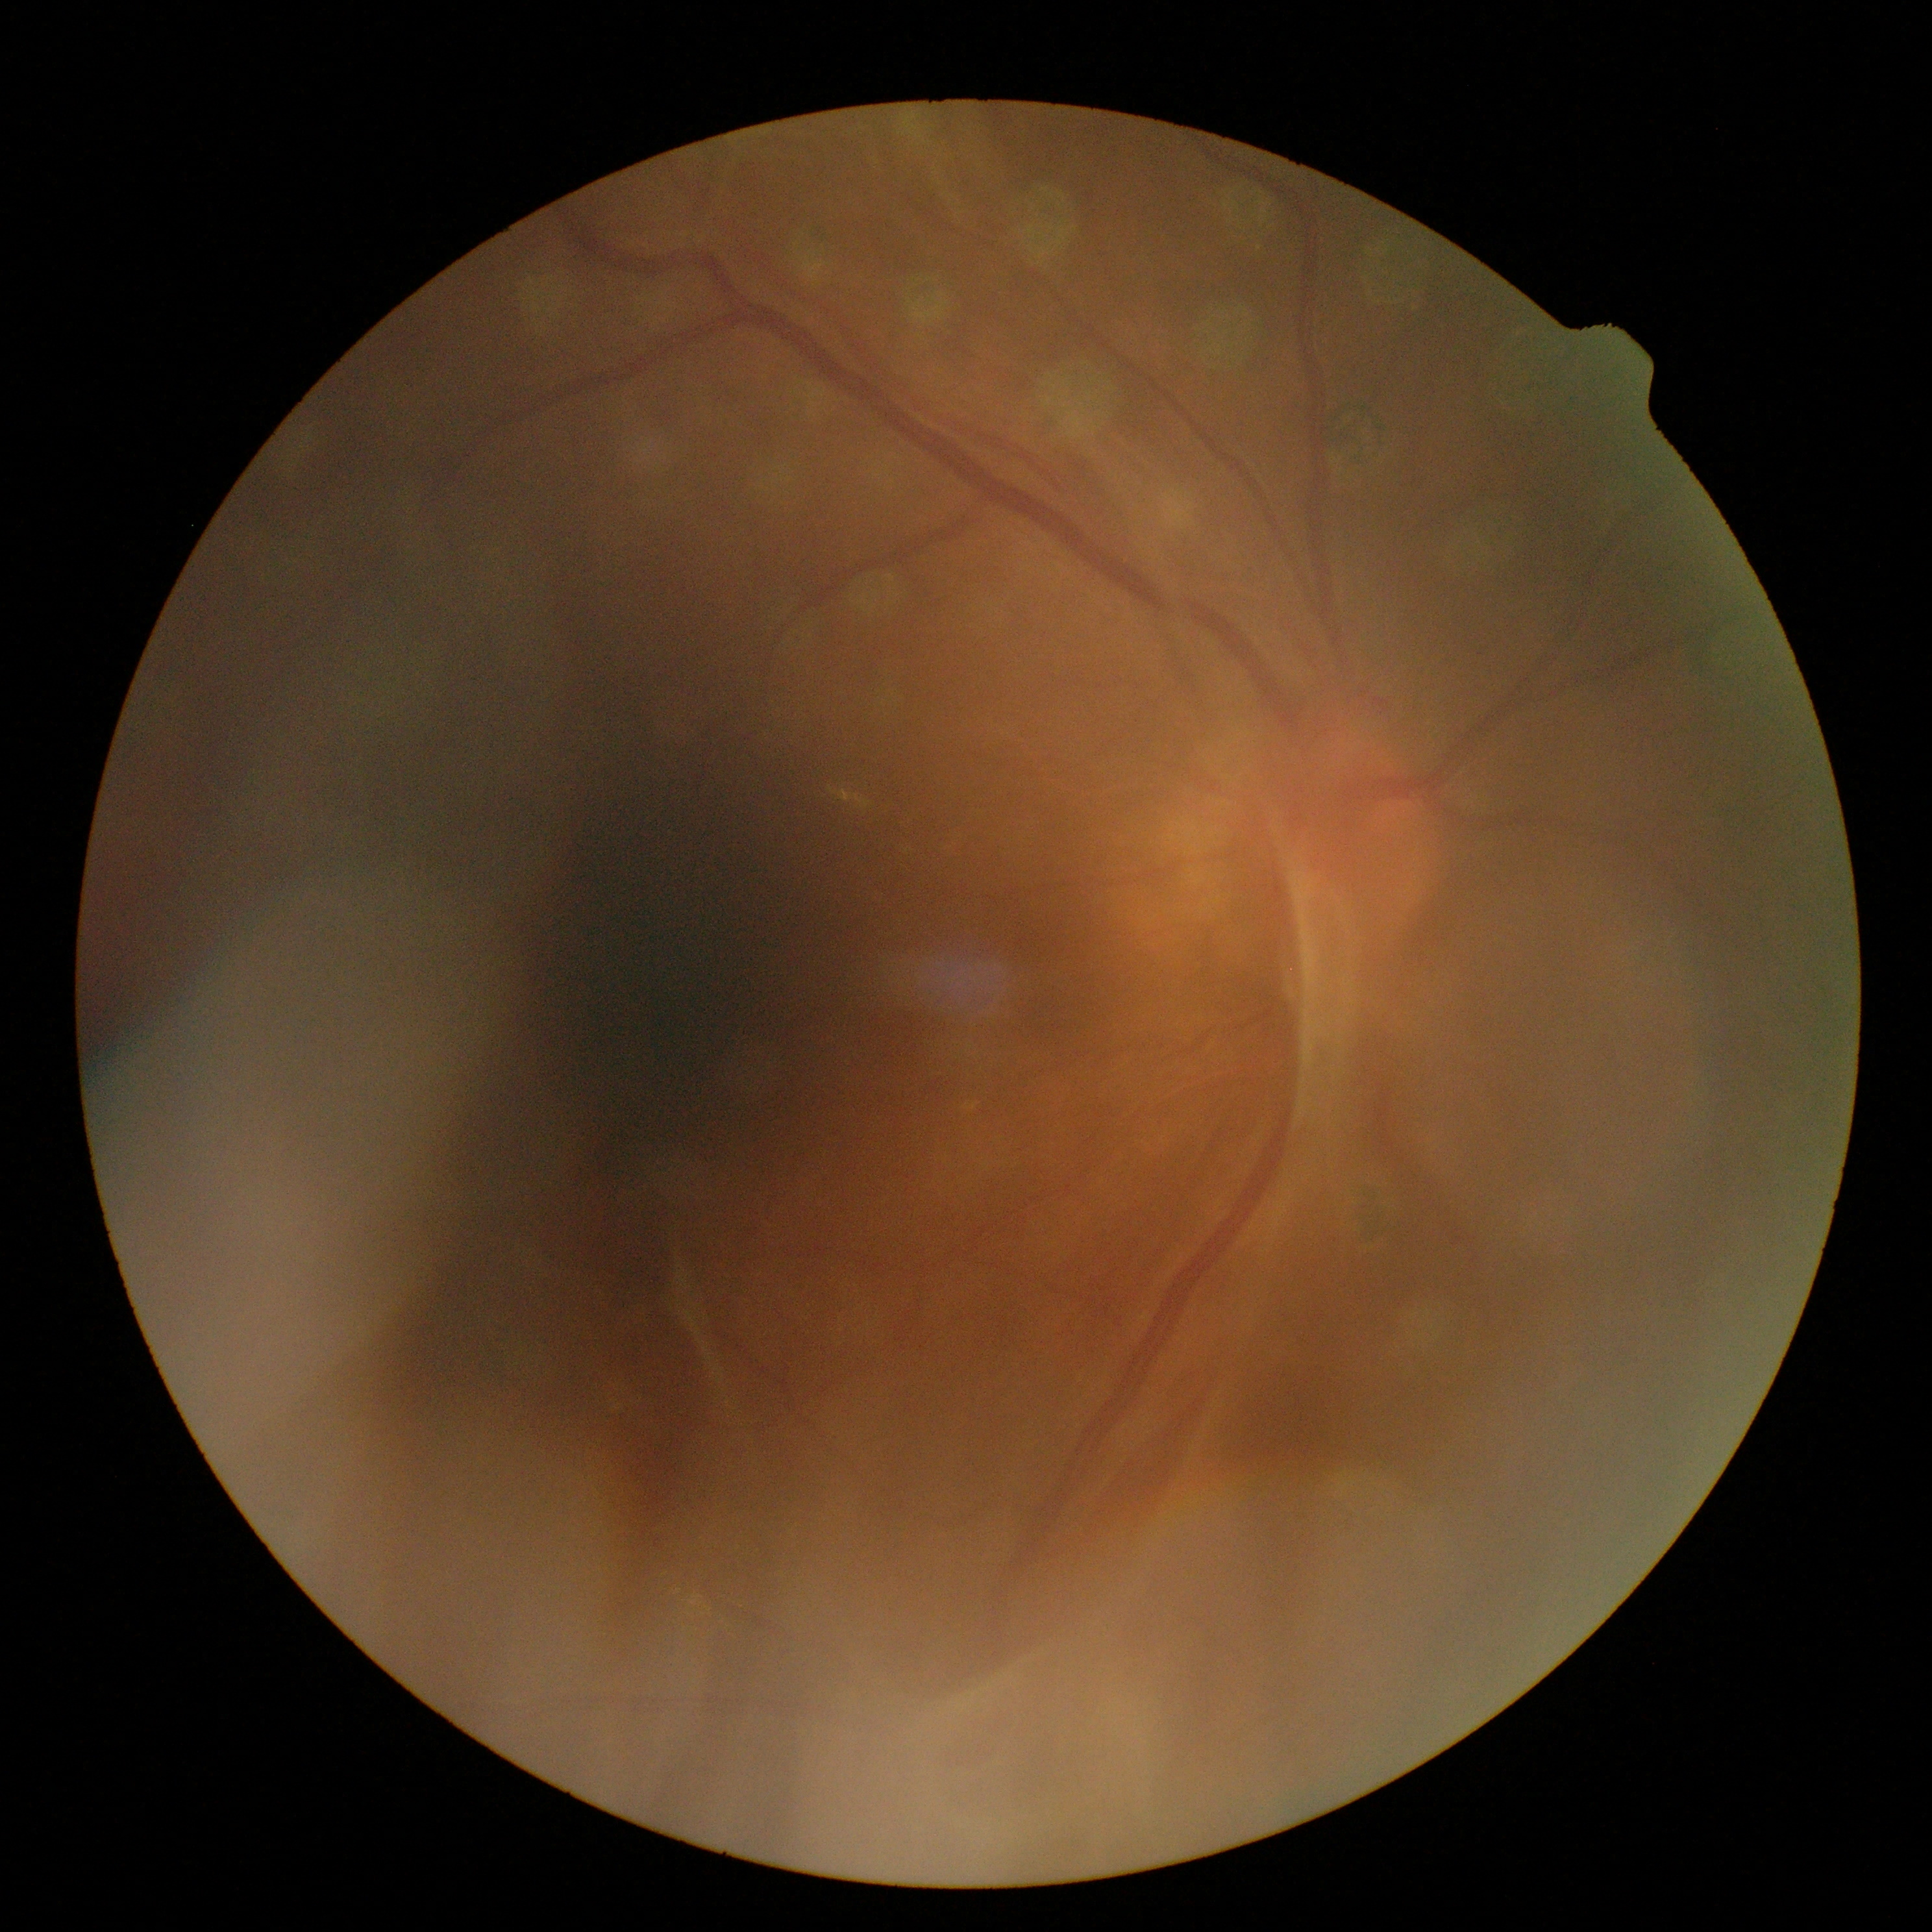
Diabetic retinopathy grade is proliferative diabetic retinopathy (4).
The retinopathy is classified as proliferative diabetic retinopathy.